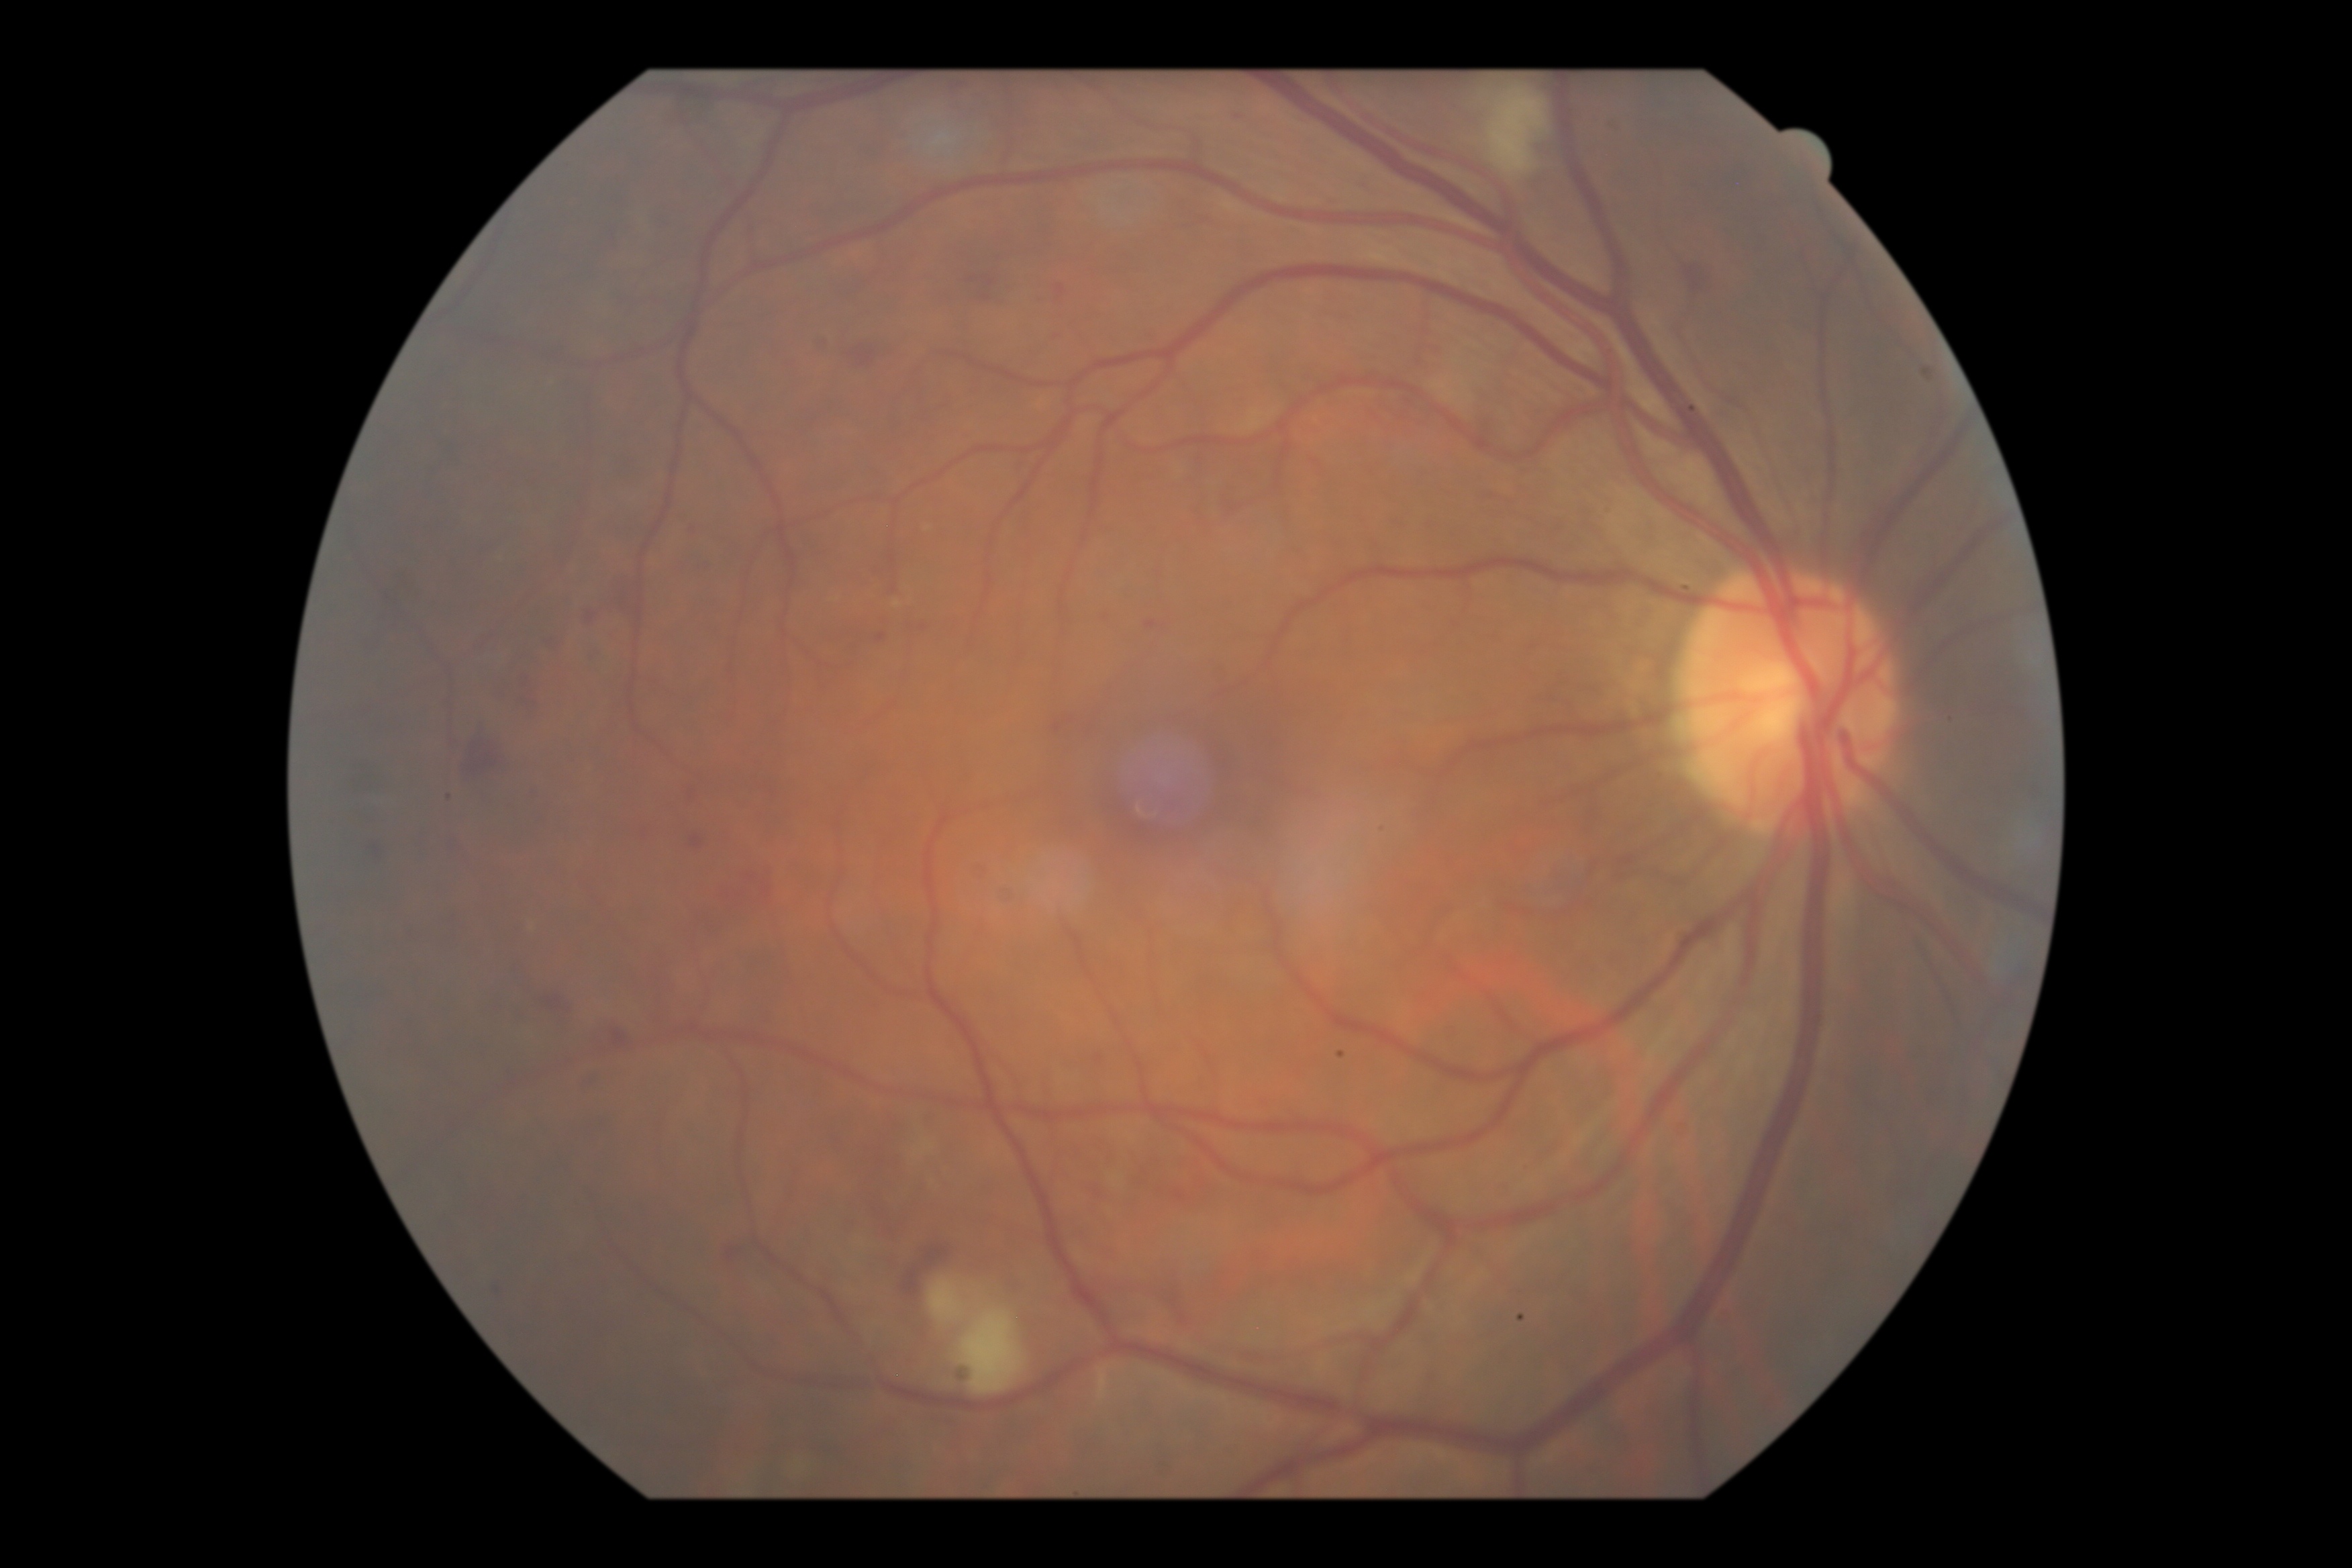

DR stage: 2/4.